Ultra-widefield (UWF) fundus image — 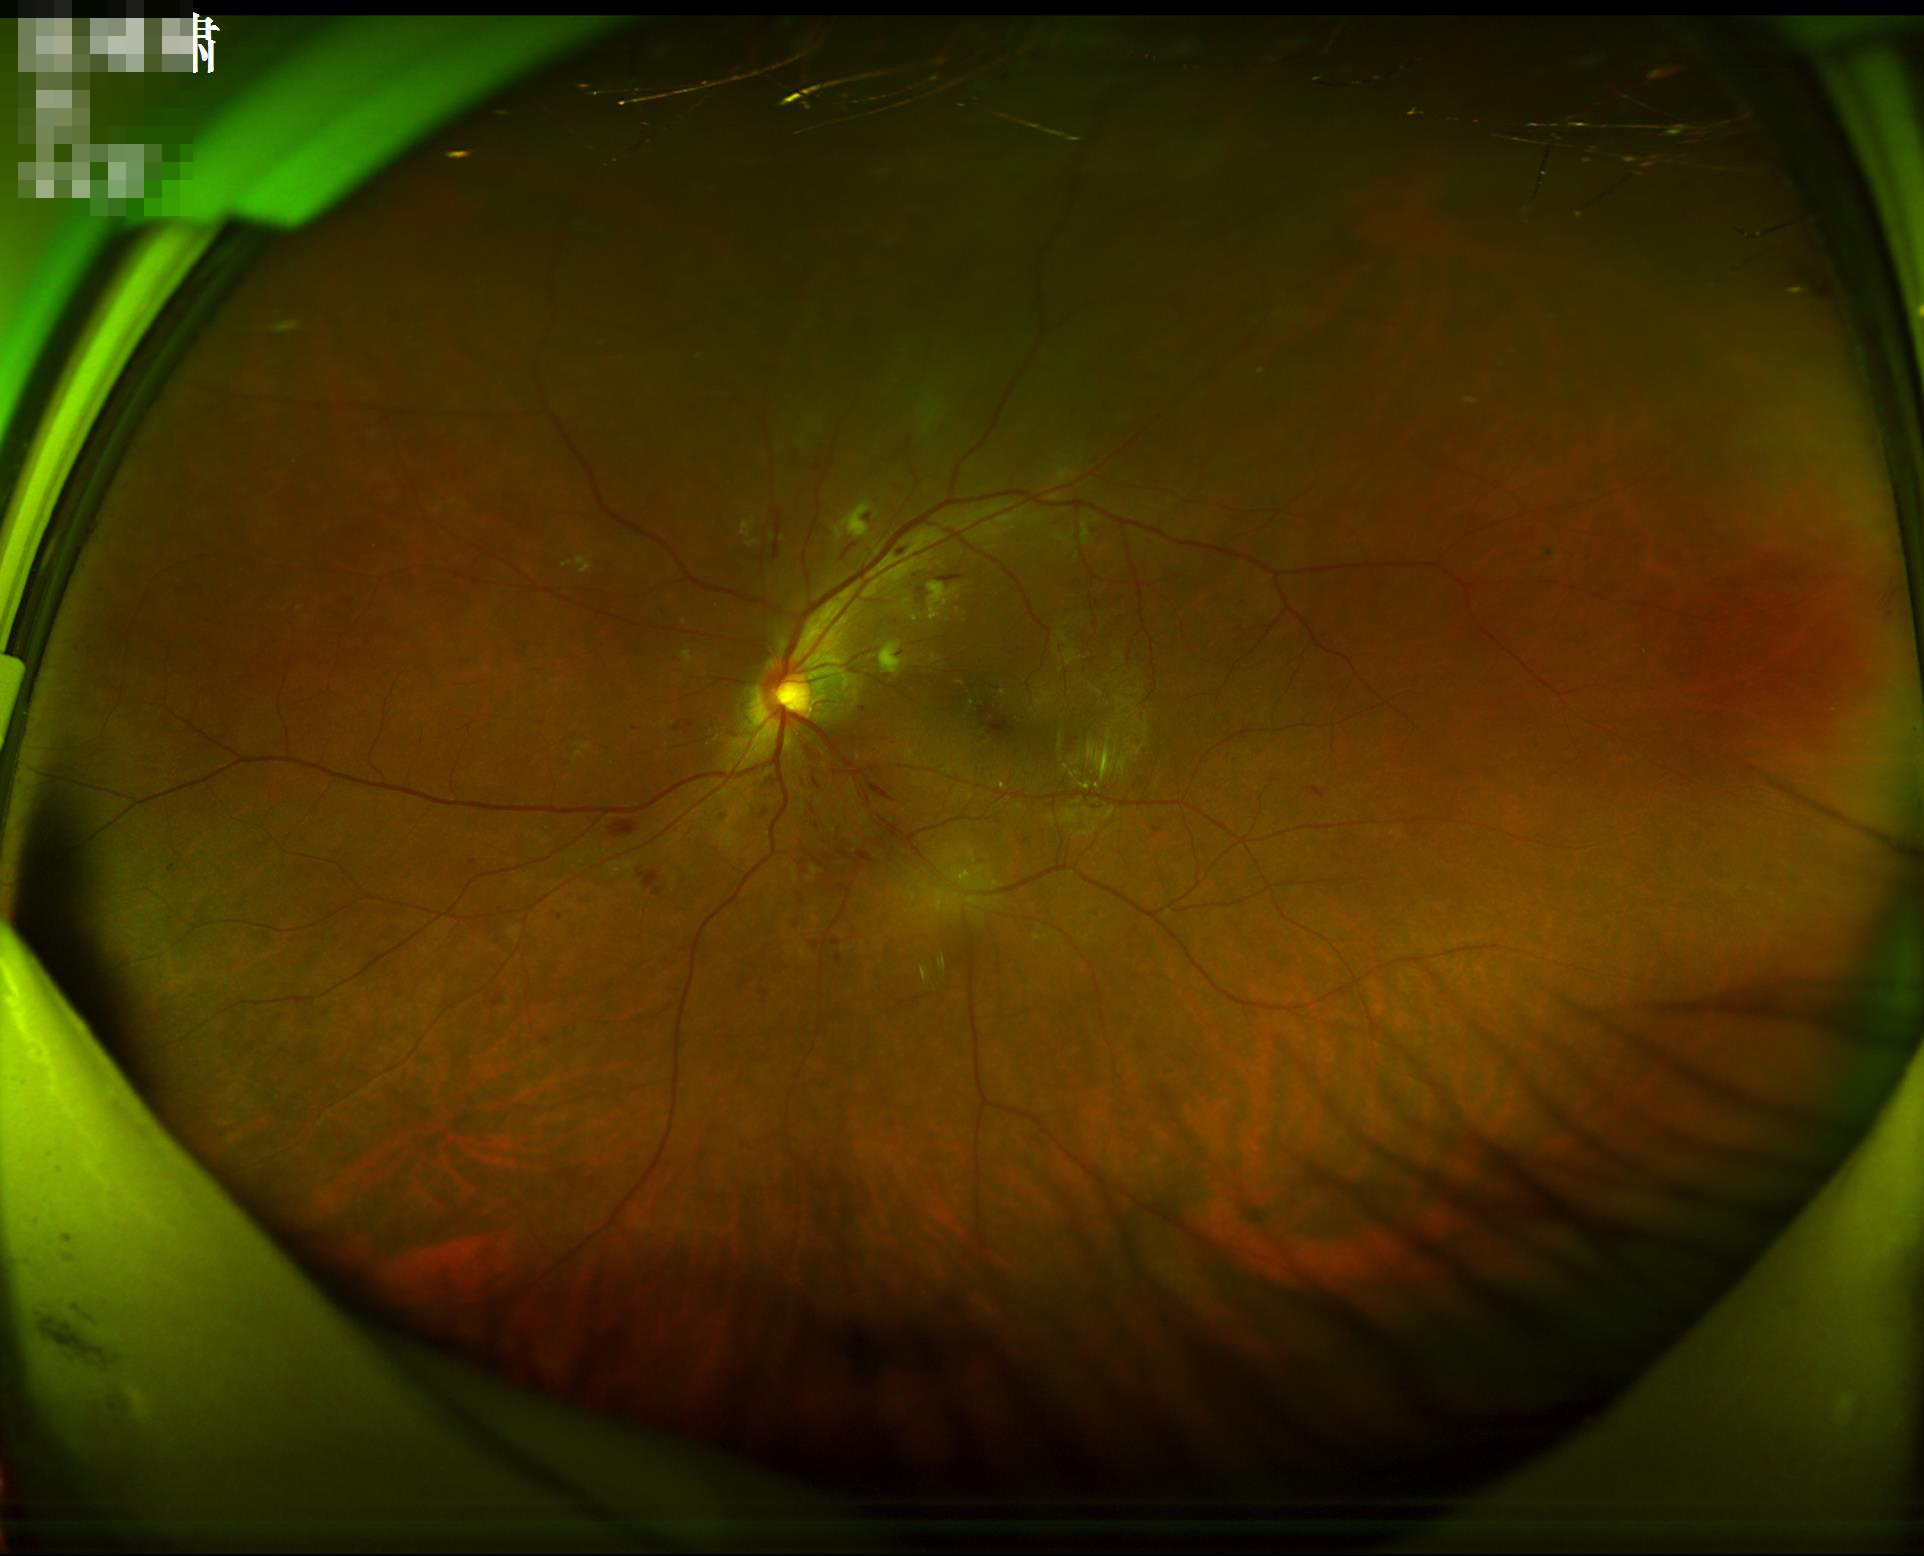
clarity: in focus
illumination: adequate
overall_quality: acceptable
contrast: good